Disc-centered field — 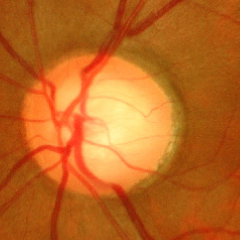
Q: Is glaucoma present?
A: Advanced glaucoma.